Wide-field retinal mosaic image — 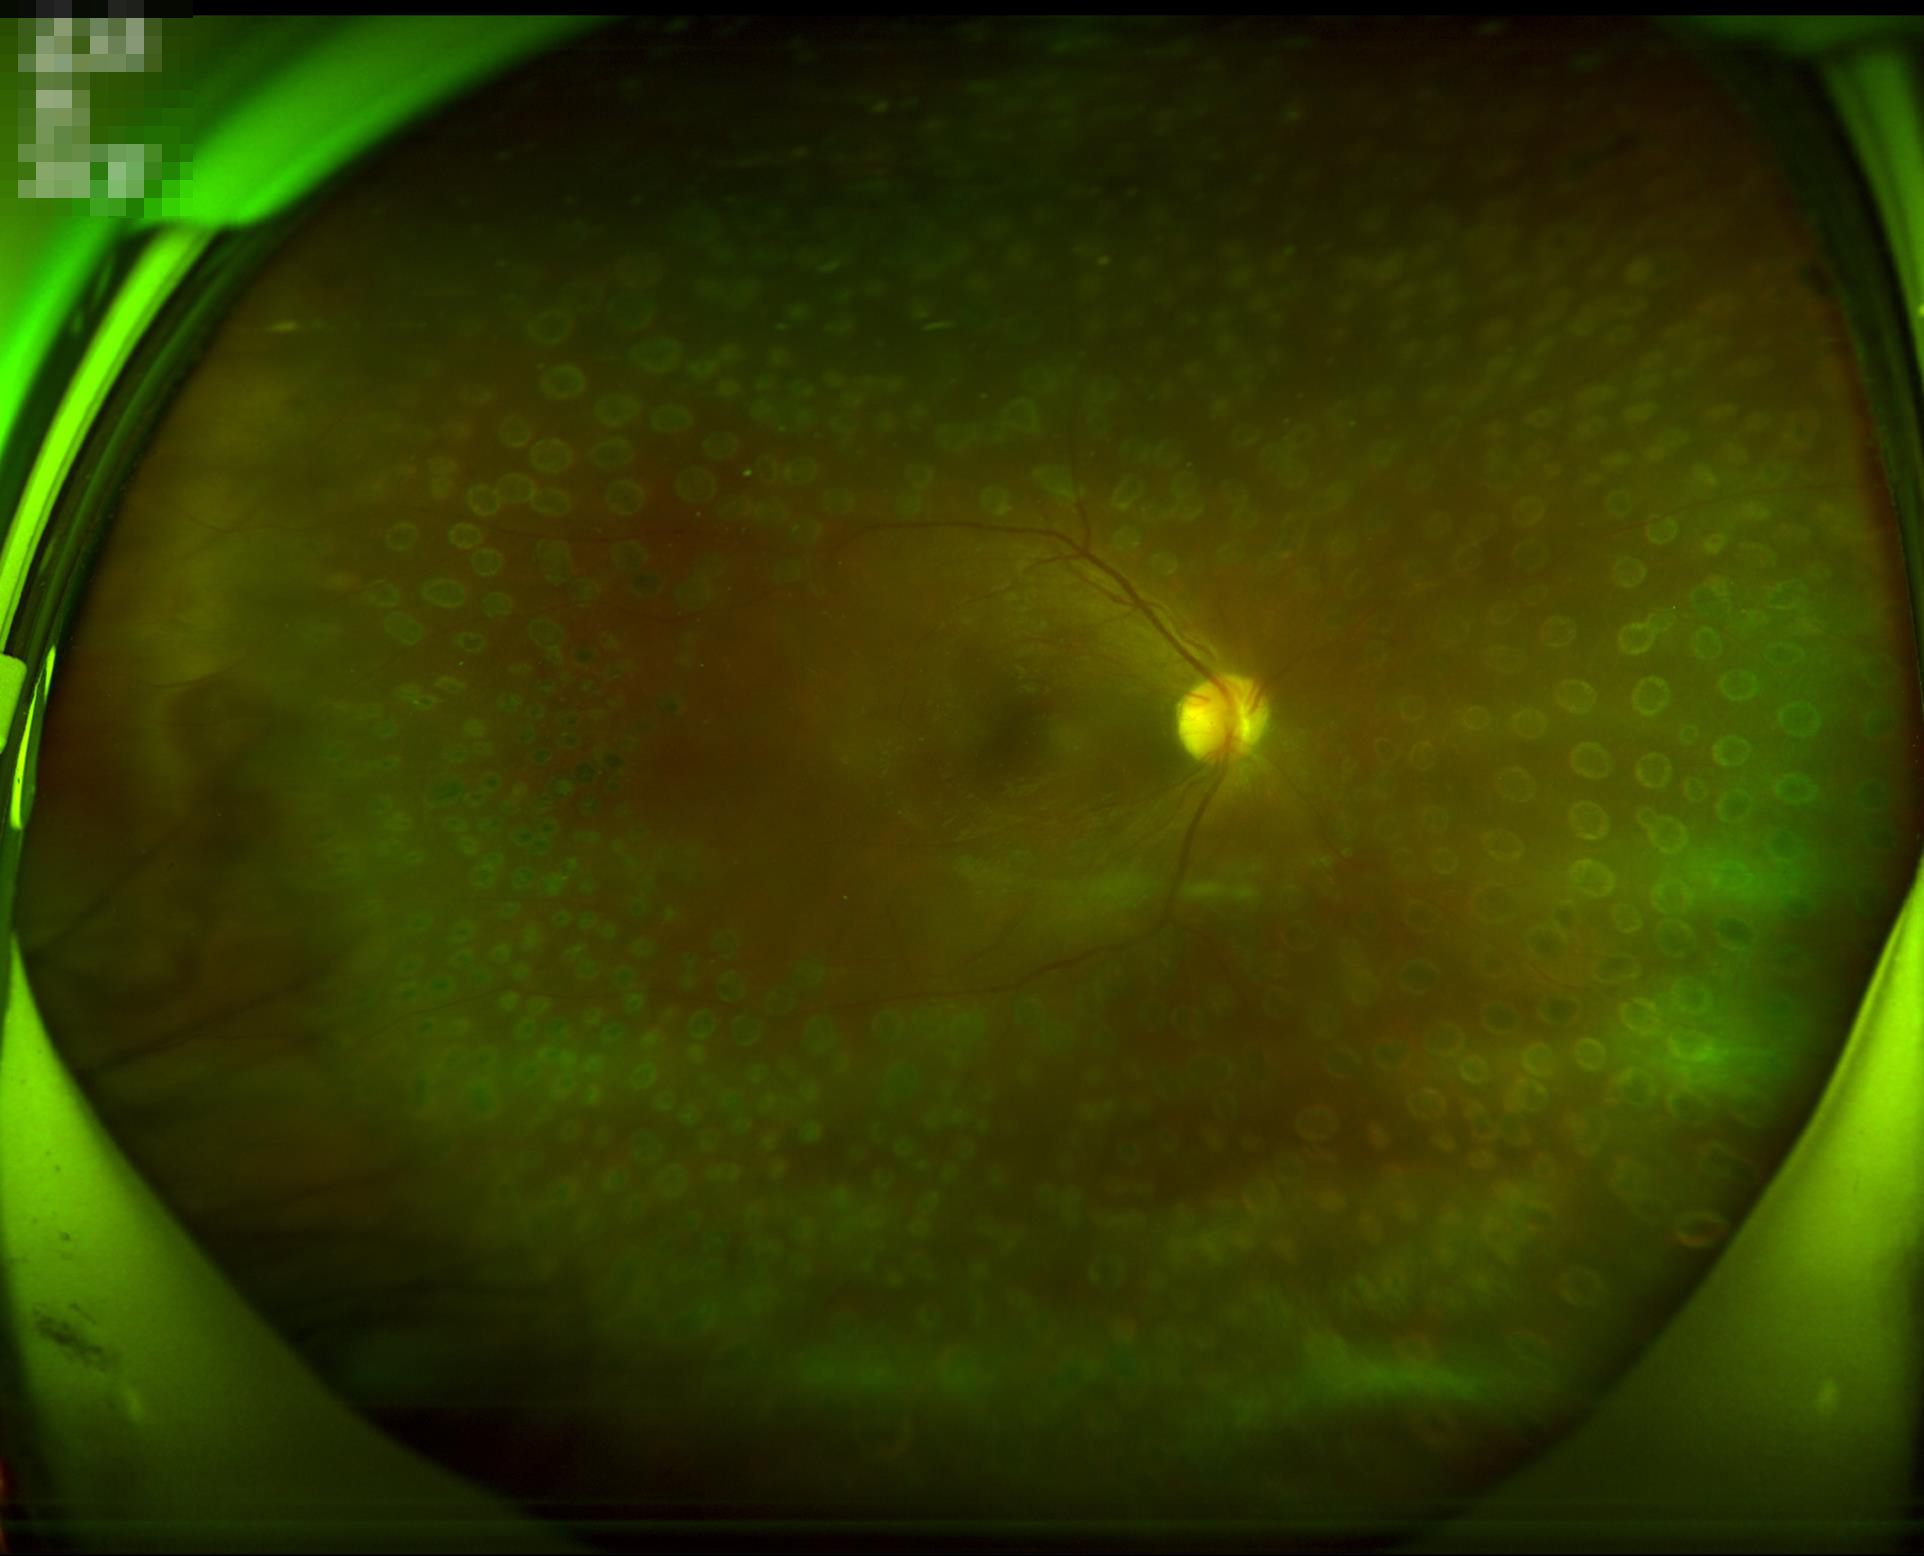 Overall image quality is good.
Contrast is good.
No over- or under-exposure.
Optic disc, vessels, and background are in focus.